2352 by 1568 pixels
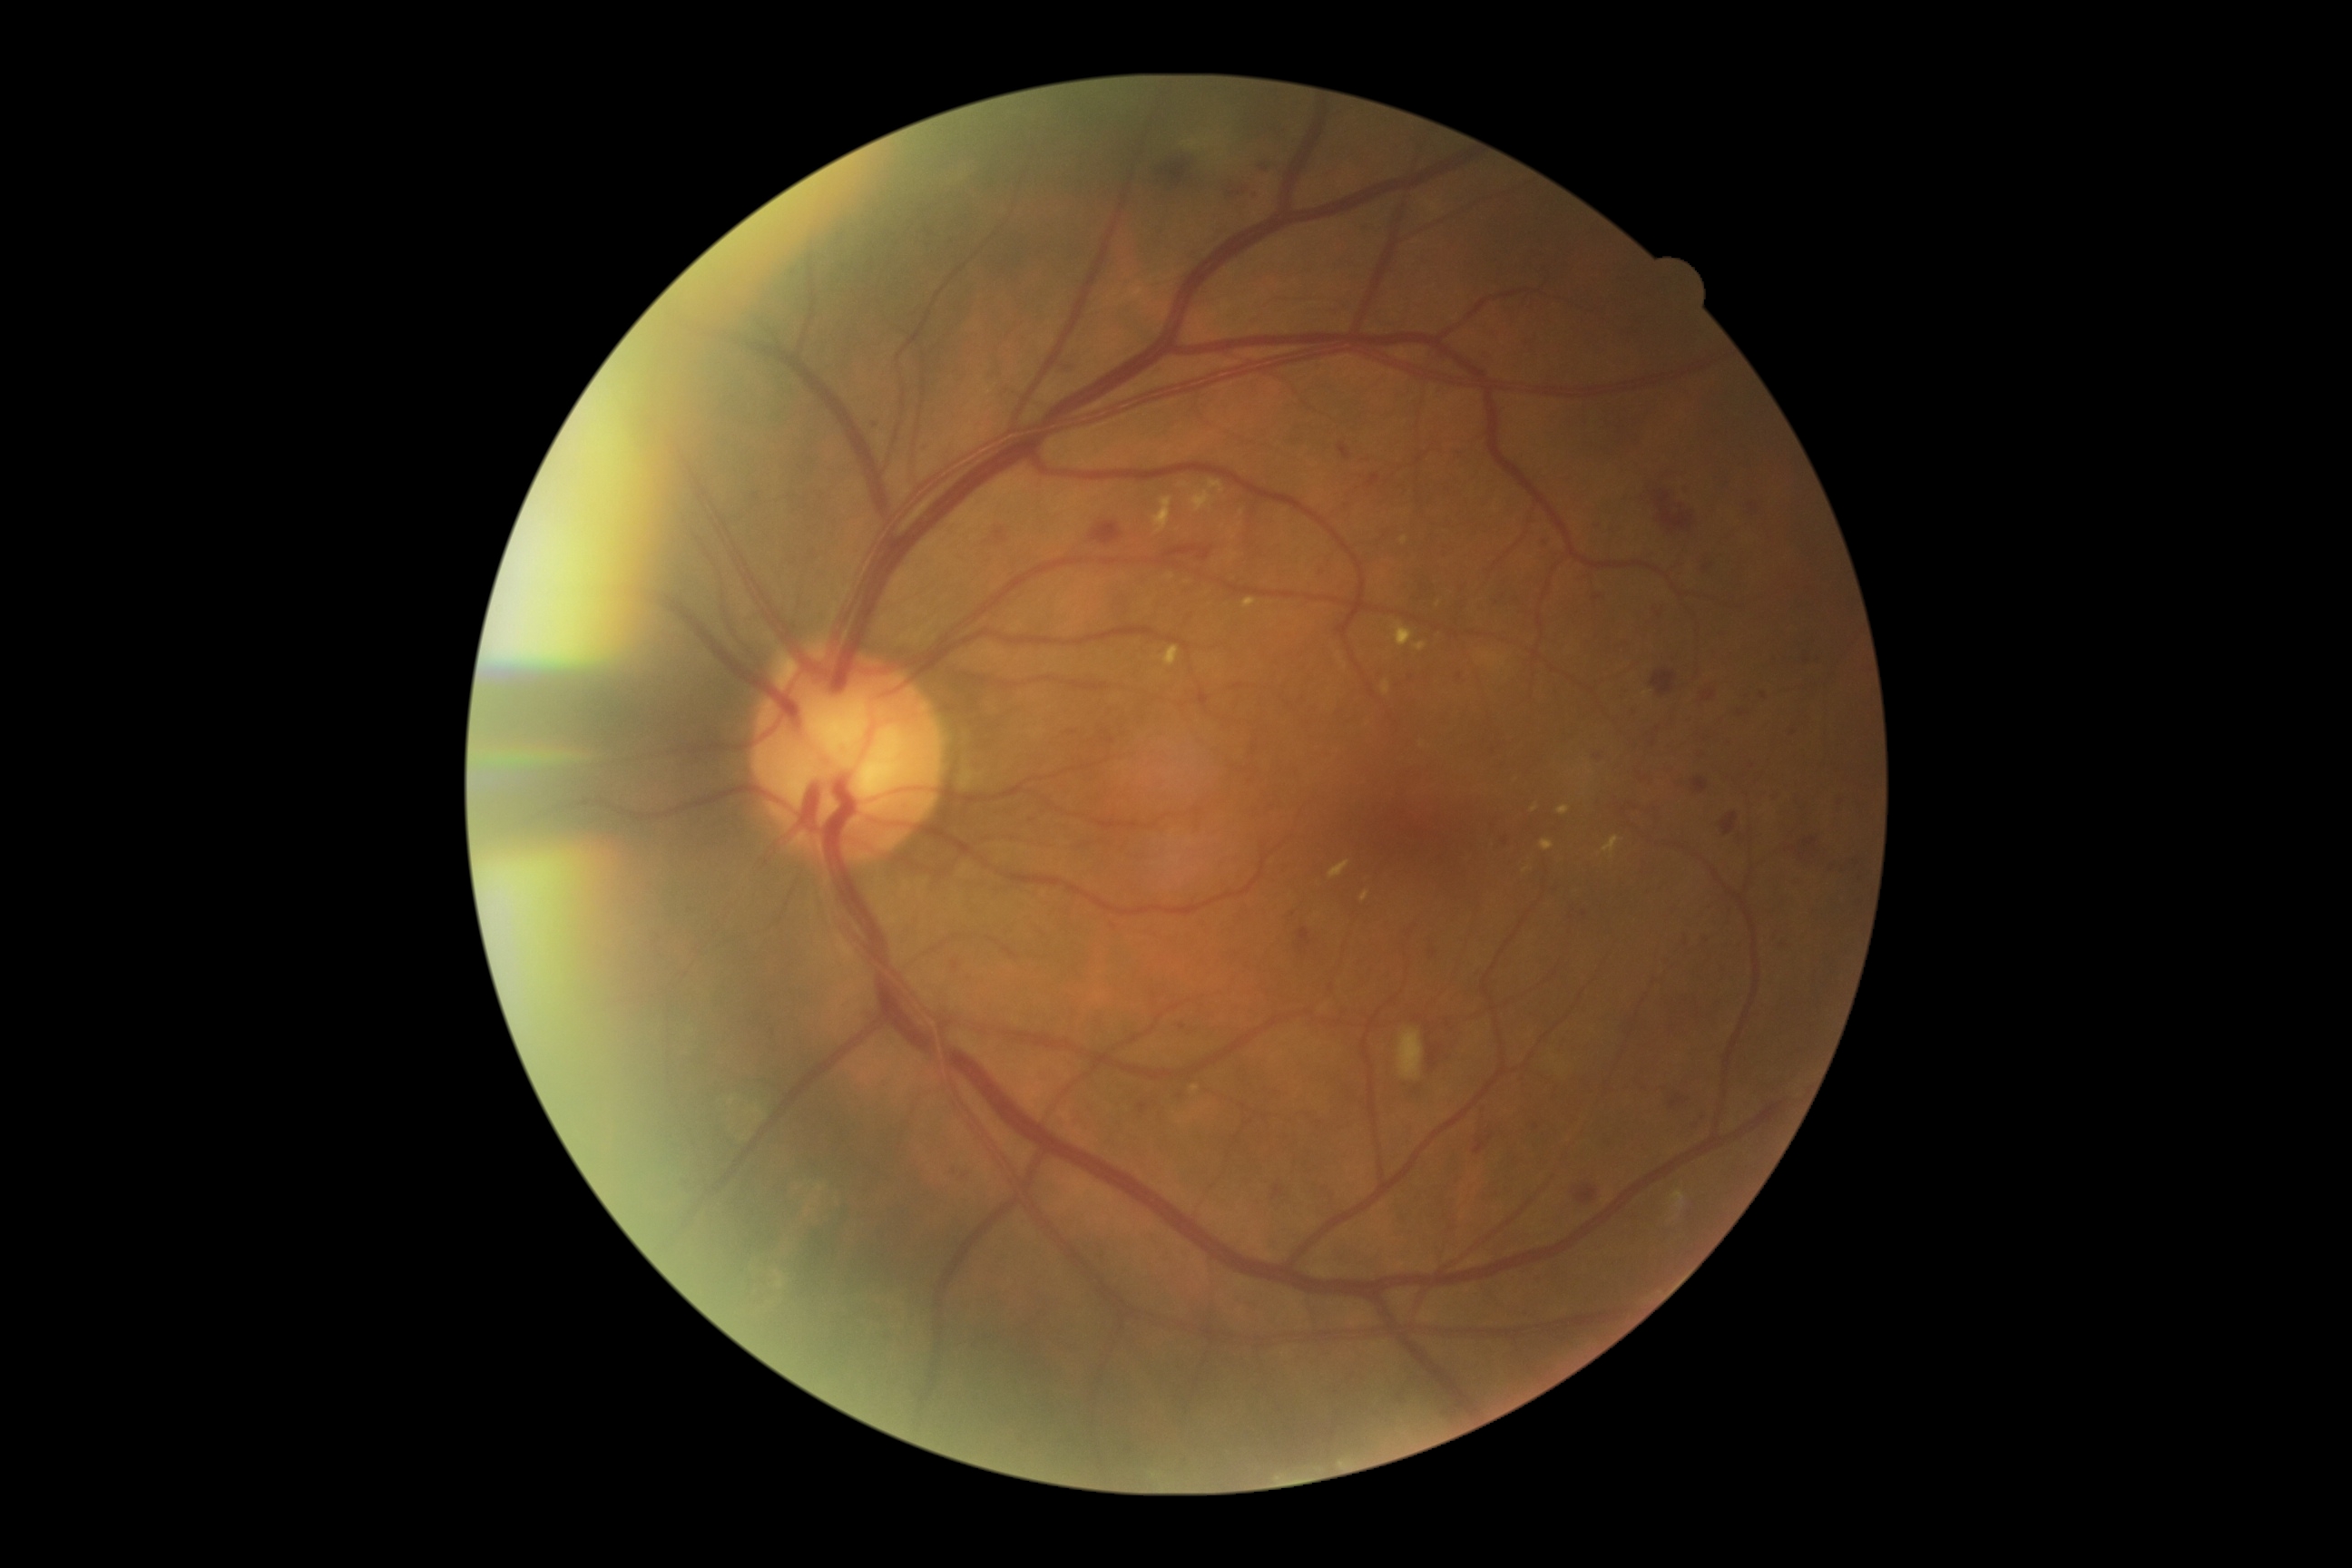 partial: true
dr_grade: 2
lesions:
  ma:
    - {"x1": 1781, "y1": 941, "x2": 1790, "y2": 950}
    - {"x1": 1594, "y1": 756, "x2": 1602, "y2": 760}
    - {"x1": 952, "y1": 961, "x2": 959, "y2": 970}
    - {"x1": 1255, "y1": 191, "x2": 1260, "y2": 199}
    - {"x1": 1371, "y1": 475, "x2": 1380, "y2": 484}
    - {"x1": 1761, "y1": 692, "x2": 1767, "y2": 700}
    - {"x1": 1179, "y1": 1024, "x2": 1186, "y2": 1032}
    - {"x1": 1678, "y1": 485, "x2": 1690, "y2": 495}
  ma_small_centers:
    - 1777/793
    - 1659/616
    - 1706/1116
    - 1706/569
    - 1537/1127
    - 1599/526
    - 953/1171
    - 1504/841
    - 1585/914
    - 1295/914
  he:
    - {"x1": 1631, "y1": 703, "x2": 1640, "y2": 716}
    - {"x1": 1798, "y1": 847, "x2": 1825, "y2": 865}
    - {"x1": 956, "y1": 1171, "x2": 970, "y2": 1179}
    - {"x1": 1162, "y1": 161, "x2": 1188, "y2": 188}
    - {"x1": 1338, "y1": 444, "x2": 1351, "y2": 460}
    - {"x1": 1839, "y1": 856, "x2": 1865, "y2": 868}
    - {"x1": 1592, "y1": 591, "x2": 1603, "y2": 600}
    - {"x1": 1418, "y1": 1028, "x2": 1465, "y2": 1083}
    - {"x1": 1692, "y1": 778, "x2": 1709, "y2": 792}
    - {"x1": 1671, "y1": 1095, "x2": 1685, "y2": 1108}
    - {"x1": 1779, "y1": 939, "x2": 1792, "y2": 950}
    - {"x1": 1685, "y1": 930, "x2": 1690, "y2": 948}
    - {"x1": 1692, "y1": 1115, "x2": 1703, "y2": 1130}
    - {"x1": 1429, "y1": 943, "x2": 1440, "y2": 961}
    - {"x1": 1836, "y1": 796, "x2": 1845, "y2": 810}
    - {"x1": 1090, "y1": 522, "x2": 1122, "y2": 545}
    - {"x1": 1798, "y1": 654, "x2": 1807, "y2": 663}
    - {"x1": 1732, "y1": 709, "x2": 1750, "y2": 718}
  he_small_centers:
    - 1544/541